45° field of view. Color fundus image — 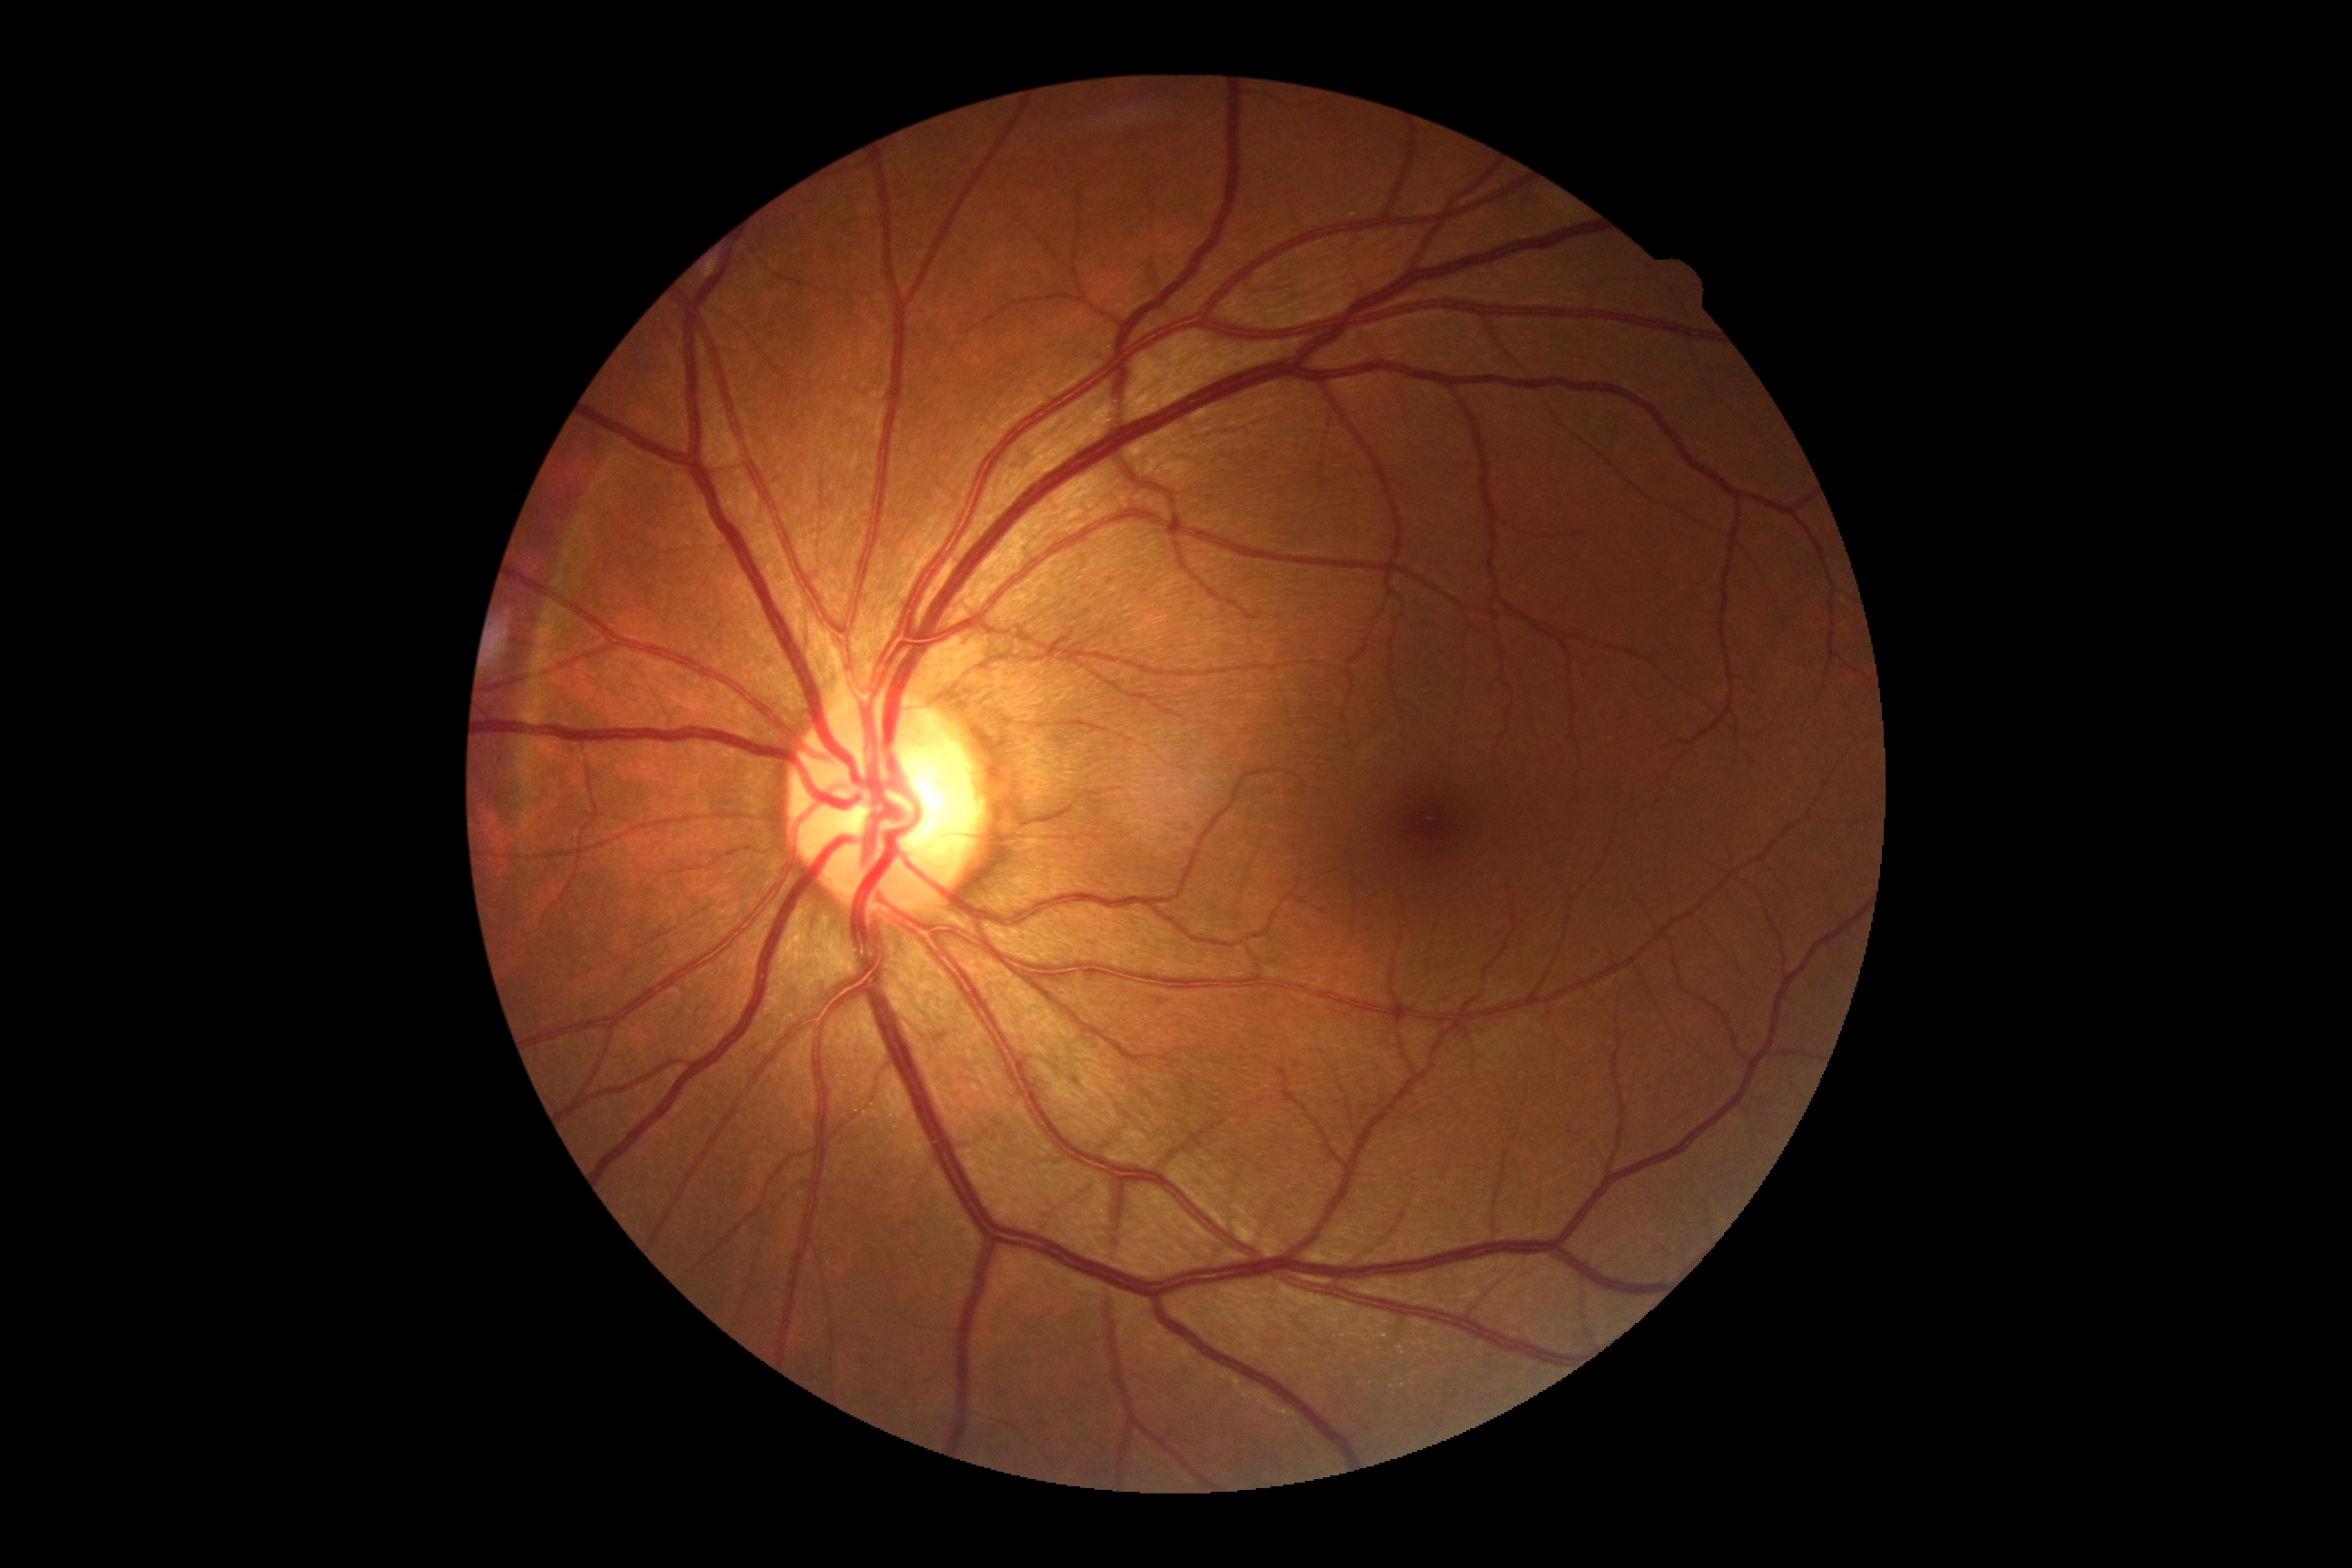

* retinopathy — no apparent diabetic retinopathy (grade 0)
* DR impression — no signs of DR